45-degree field of view
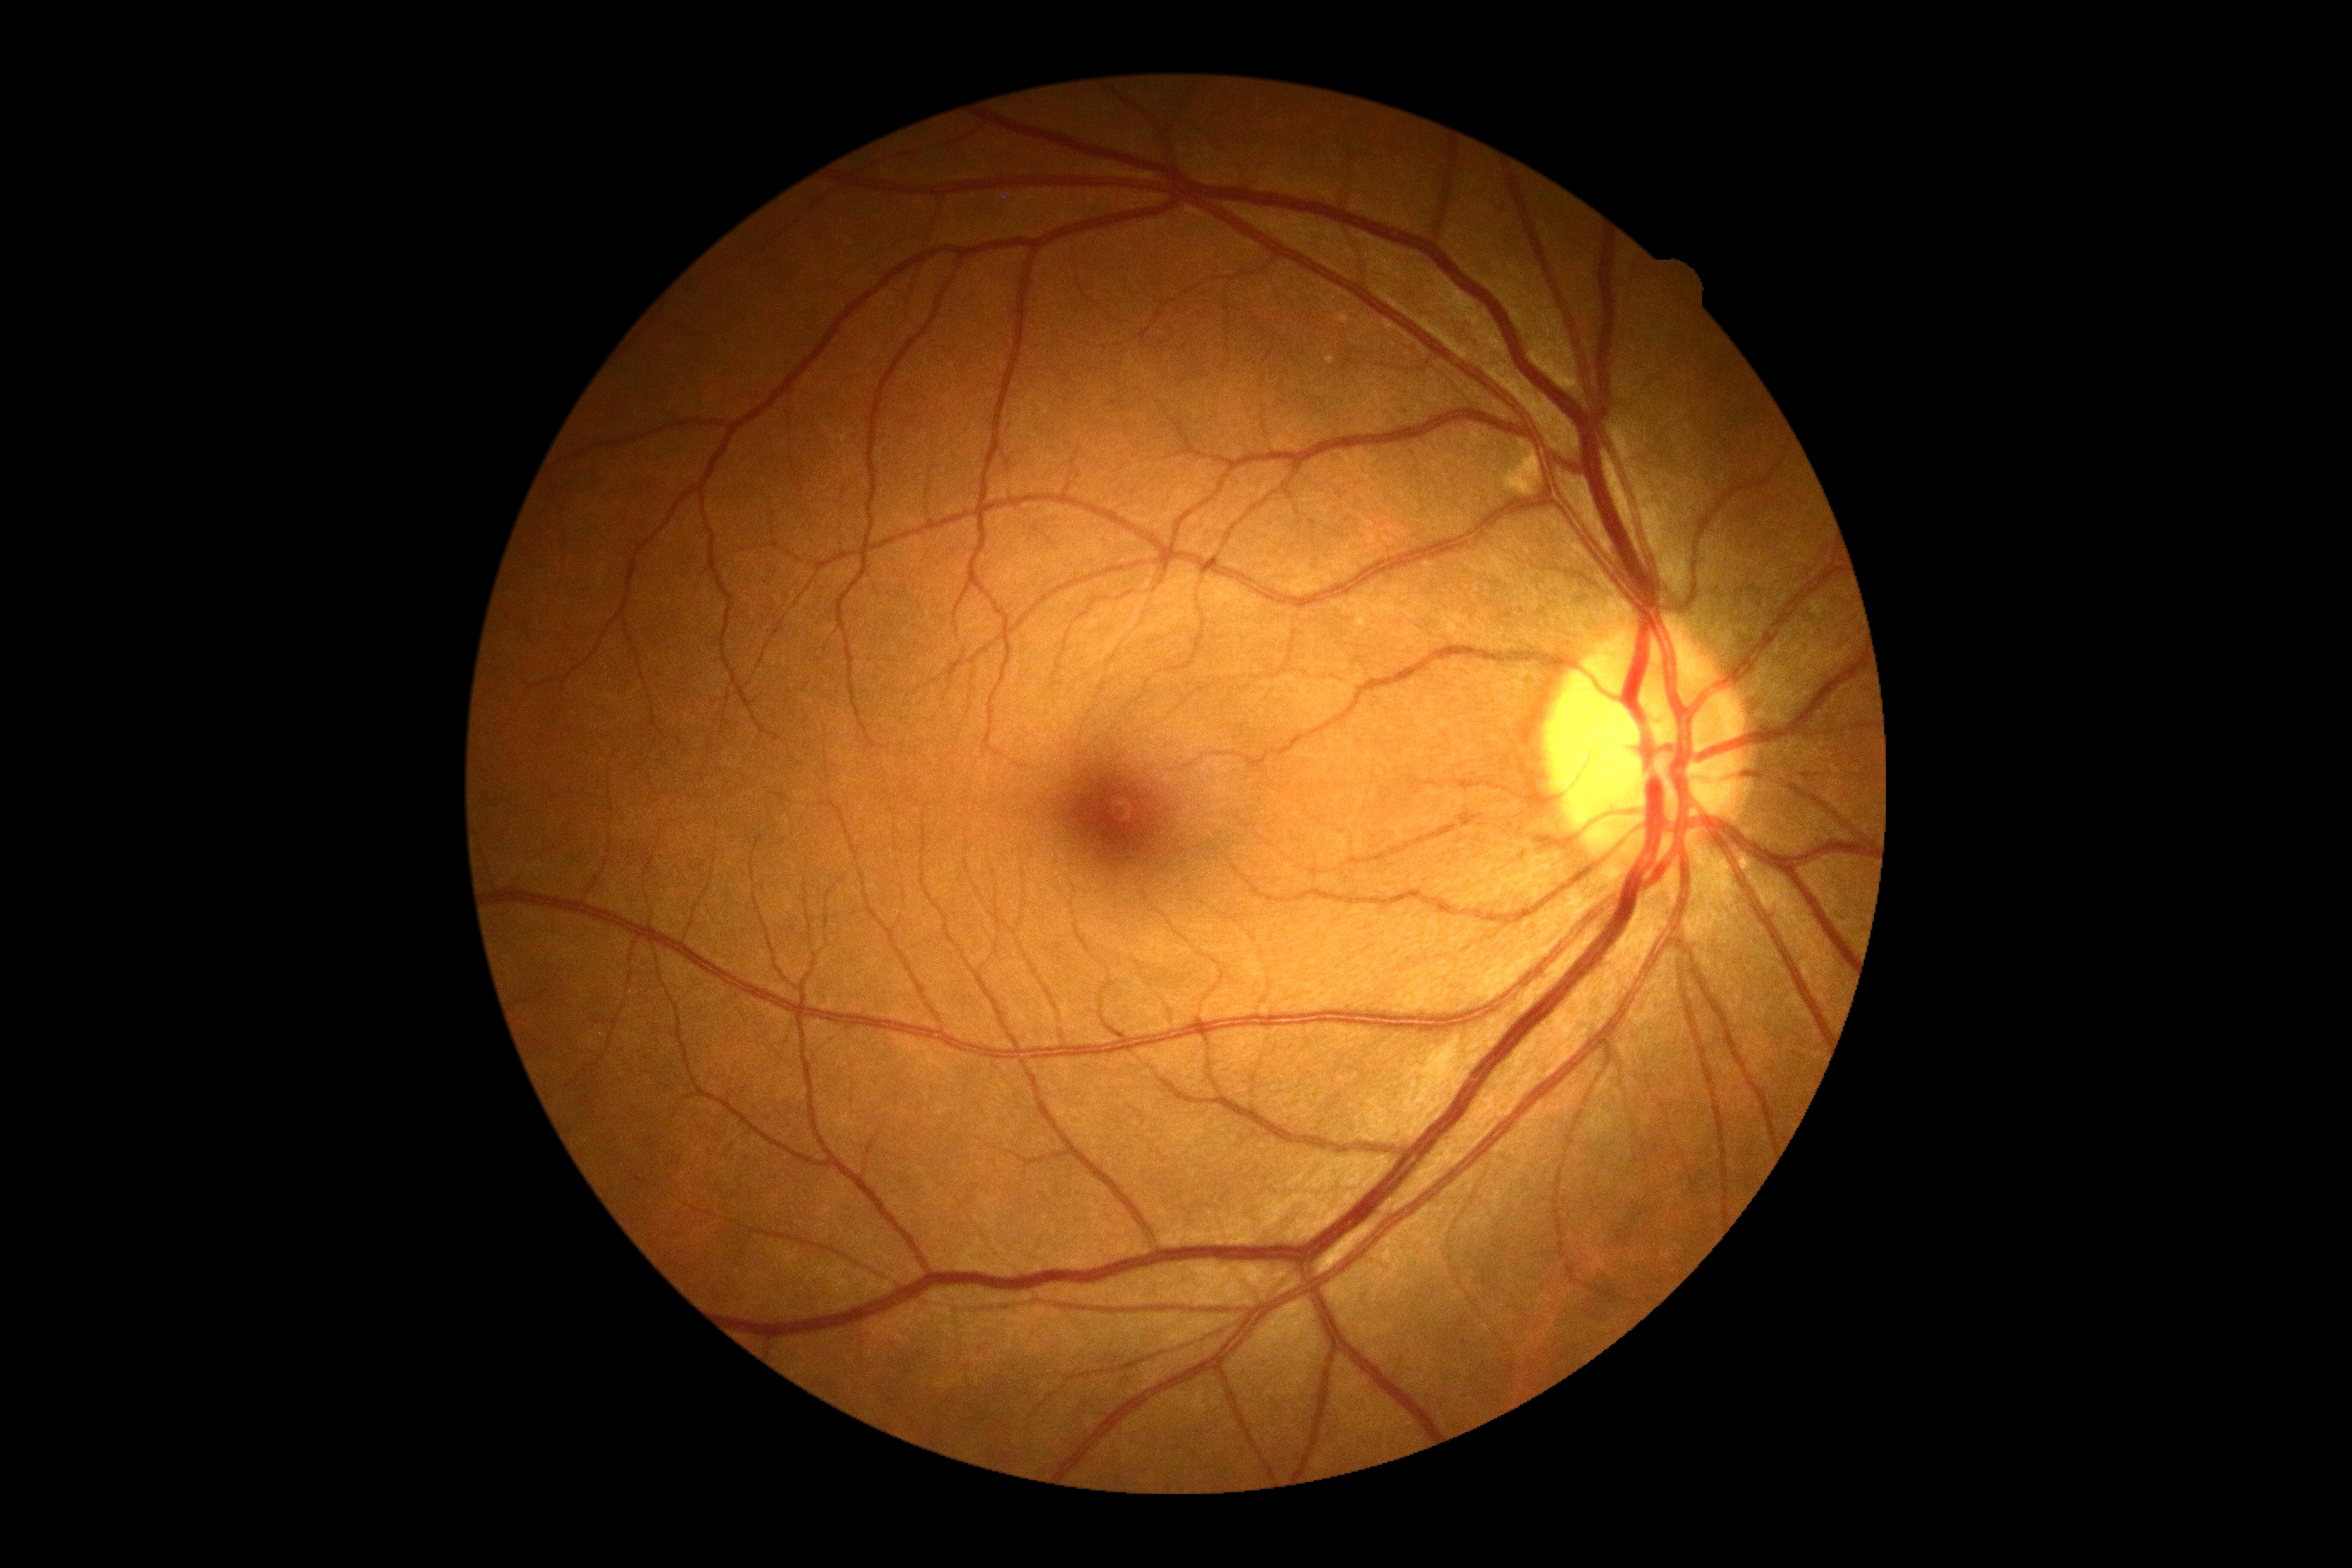
Findings:
– diabetic retinopathy severity — grade 0